Wide-field fundus photograph of an infant — 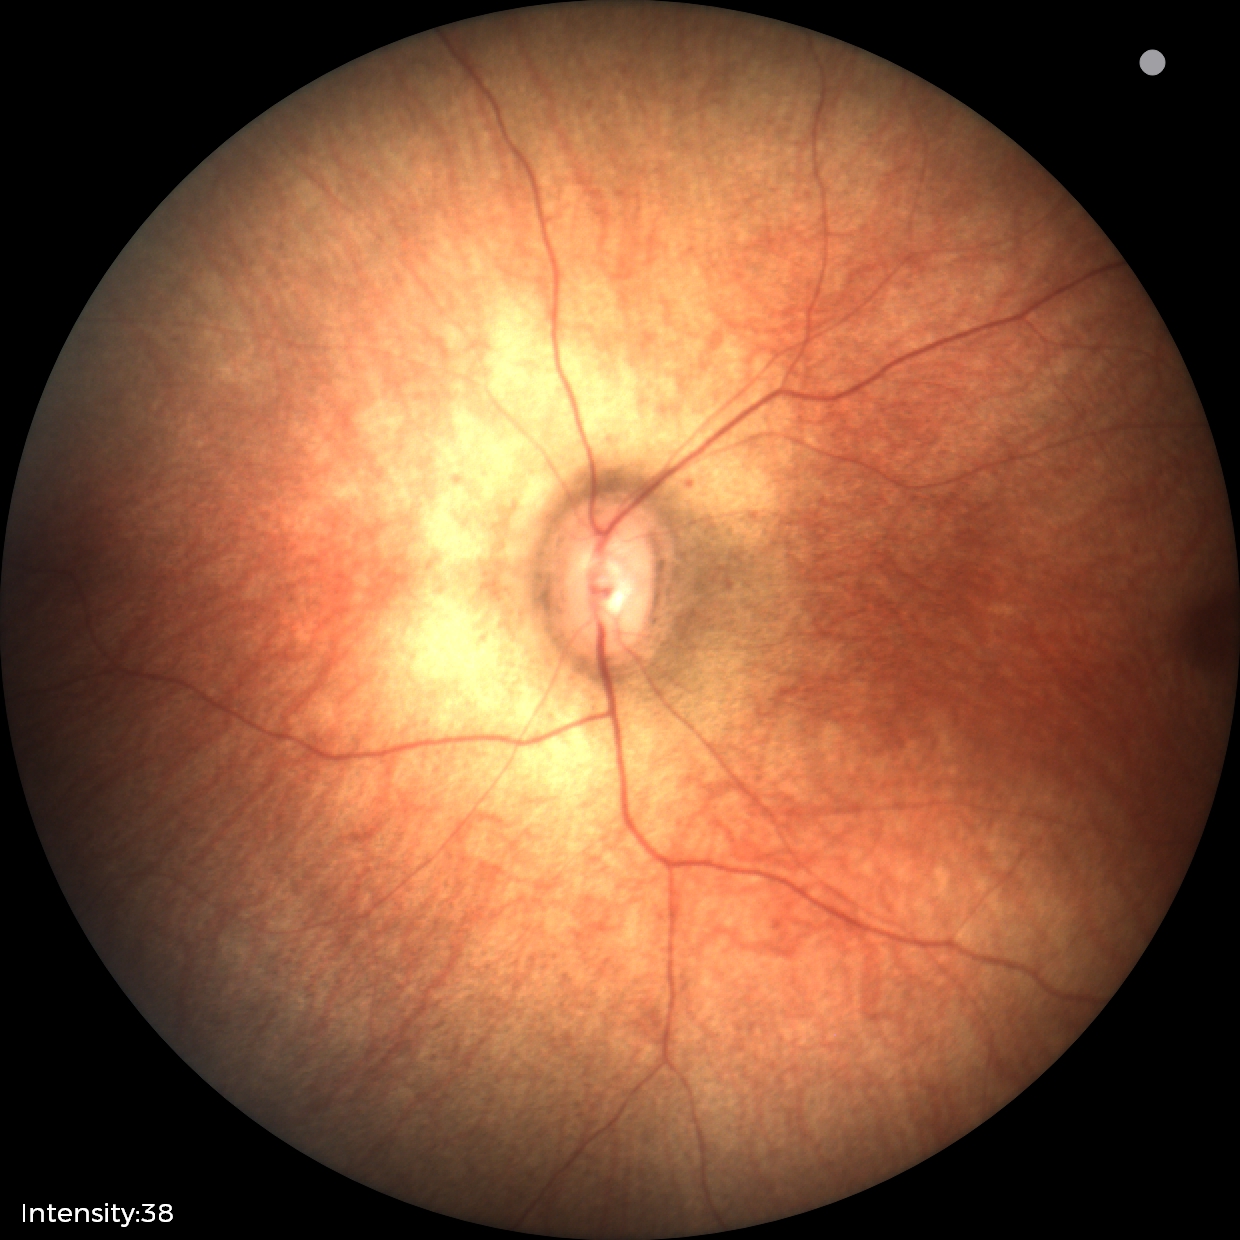
Assessment: physiological finding.